848x848, acquired with a NIDEK AFC-230, posterior pole color fundus photograph
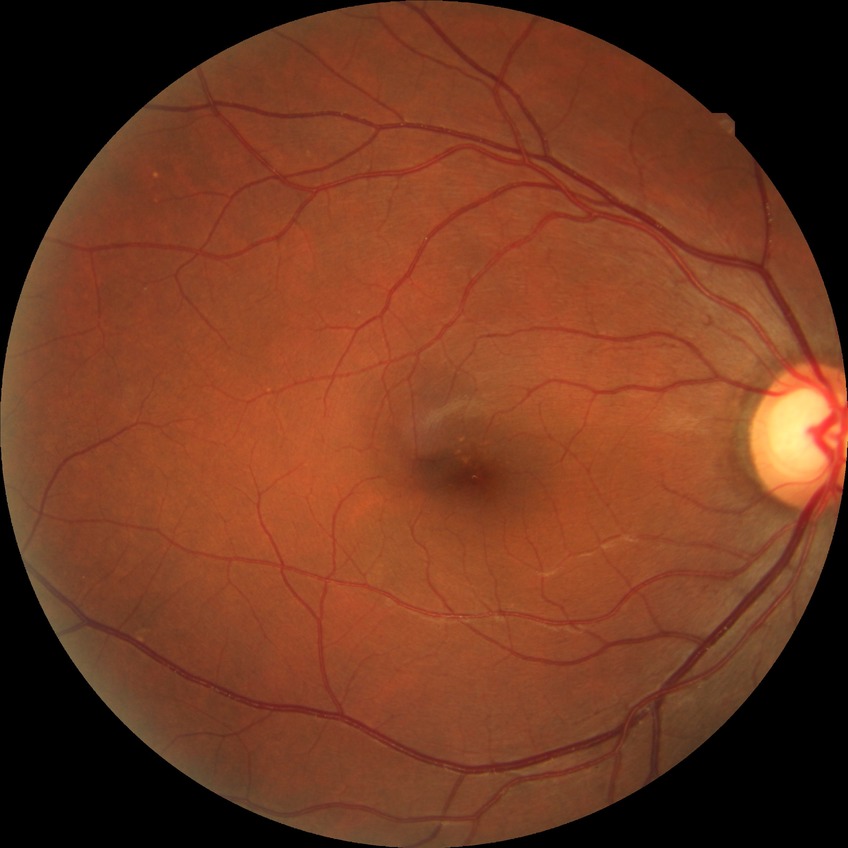 Diabetic retinopathy (DR): NDR (no diabetic retinopathy).